FOV: 45 degrees
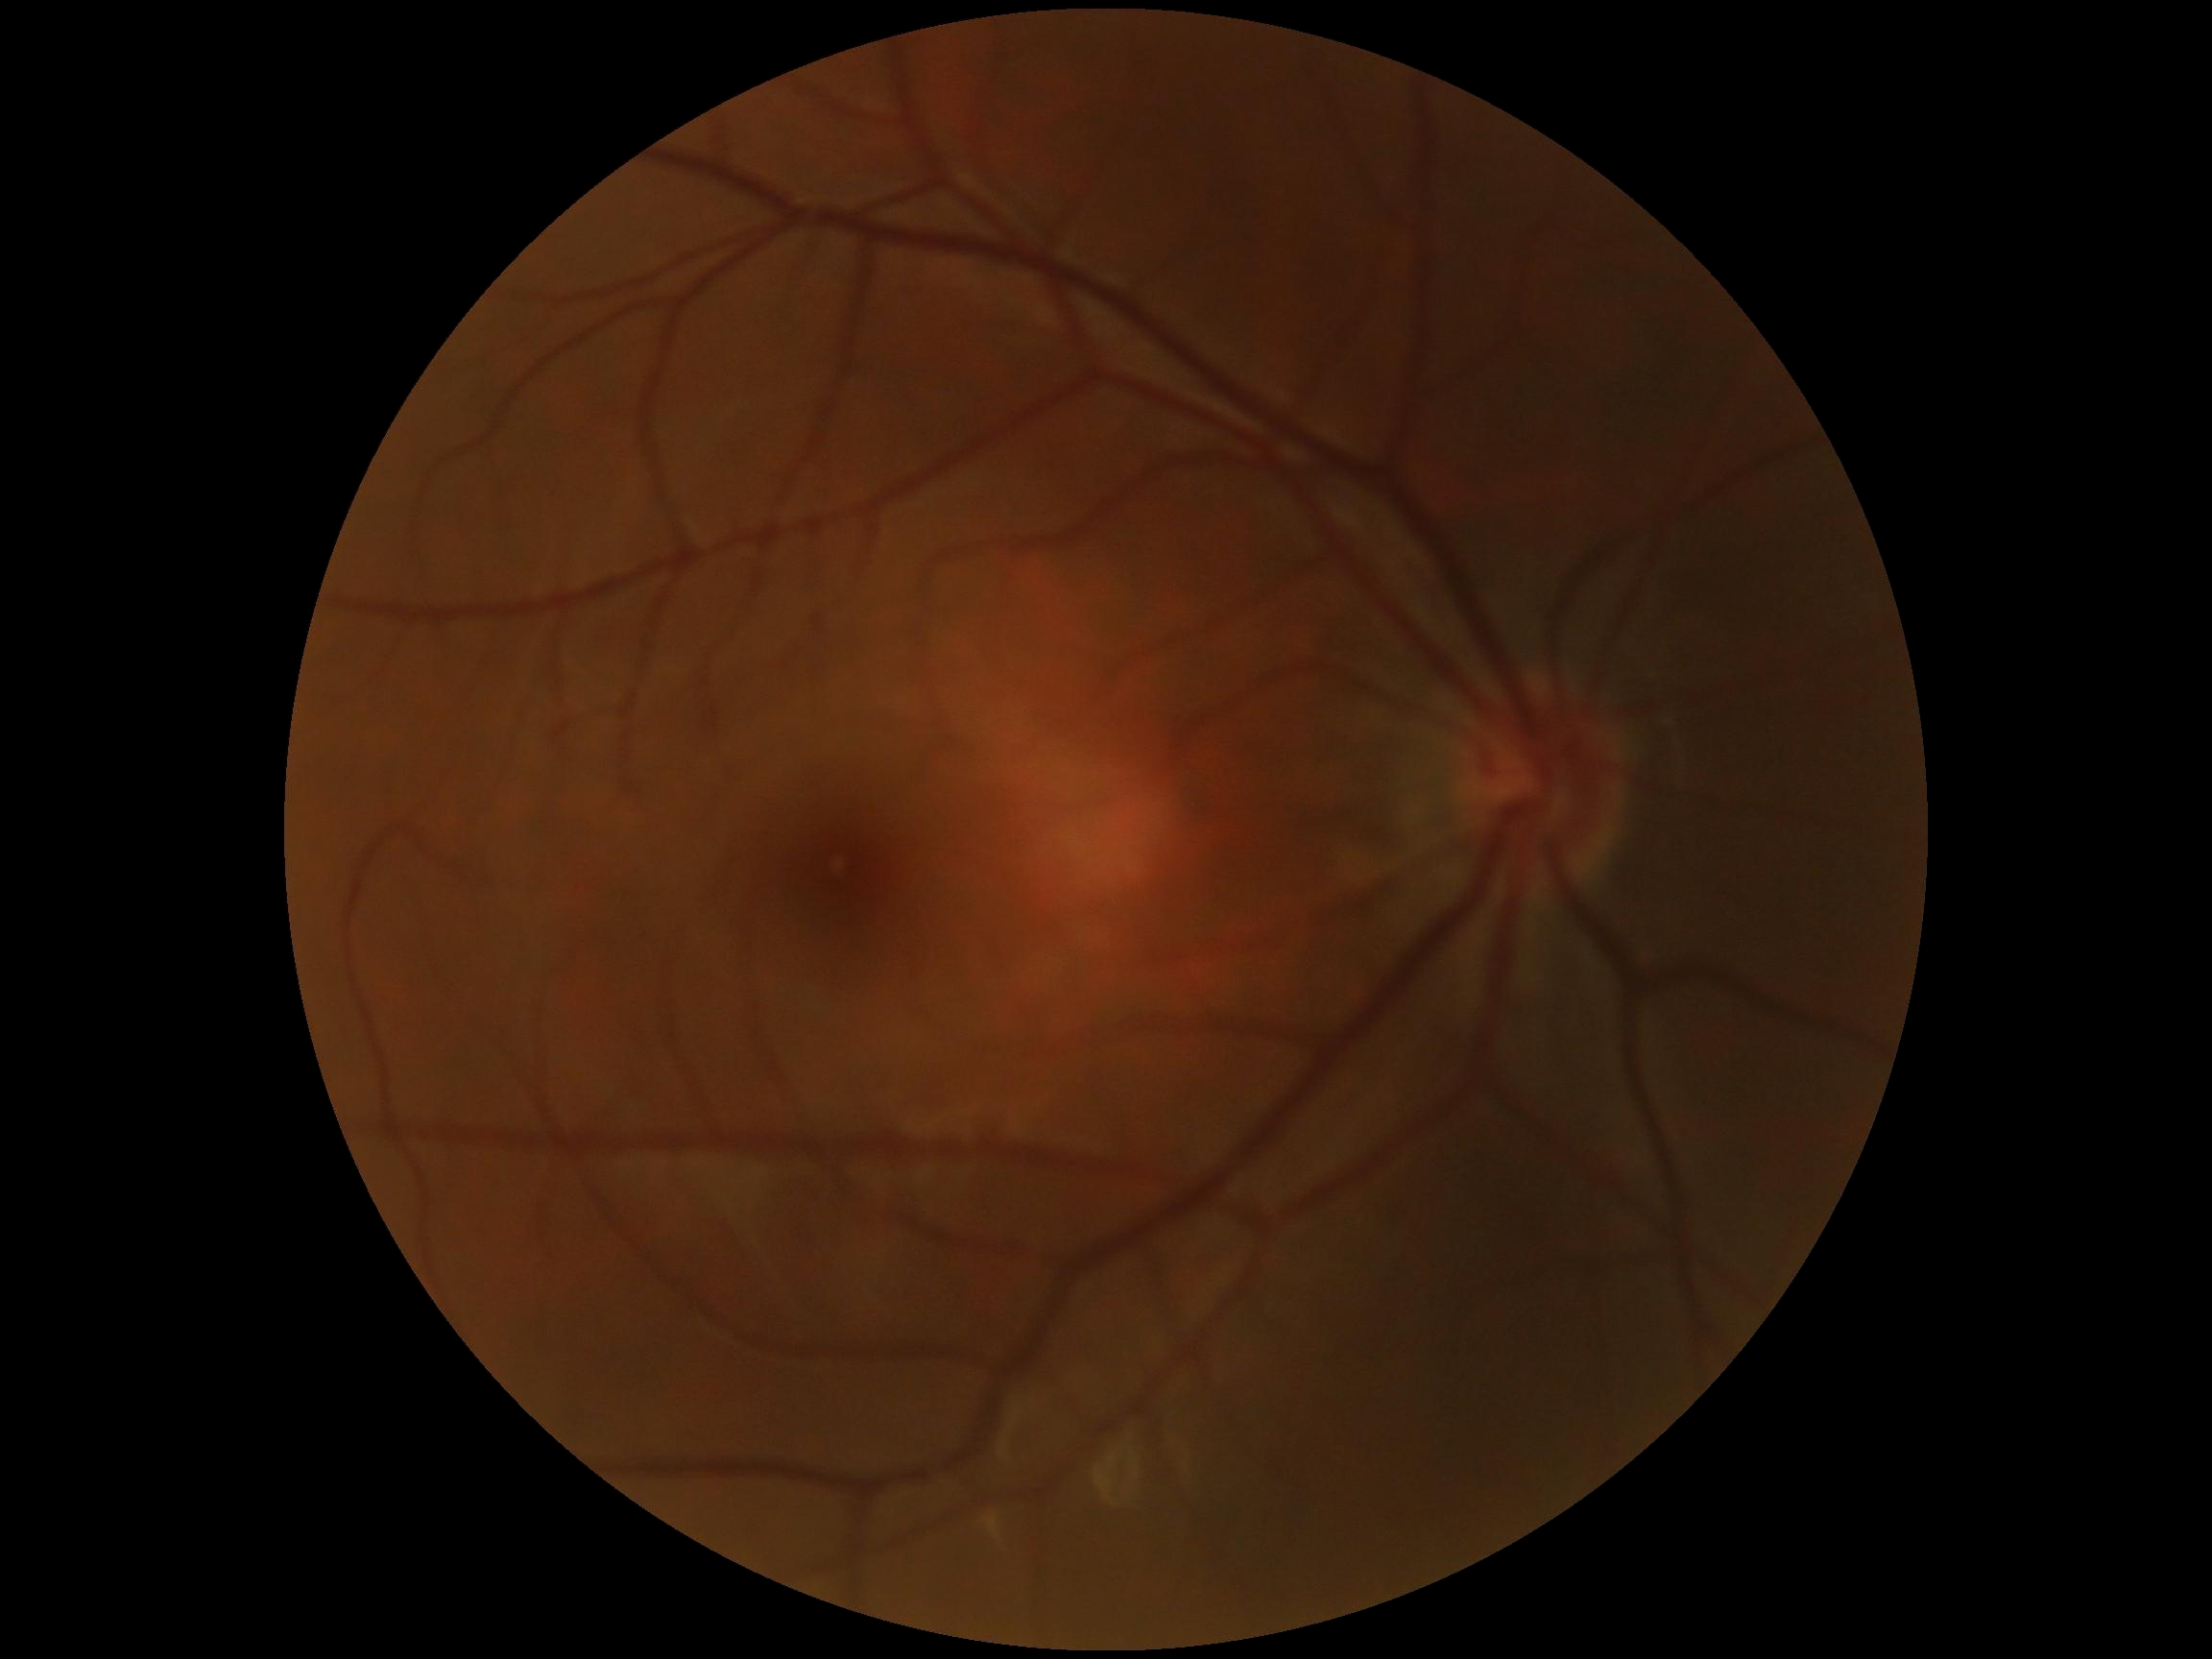
Retinopathy is grade 0 (no apparent retinopathy).